Color fundus image, 2212x1659px
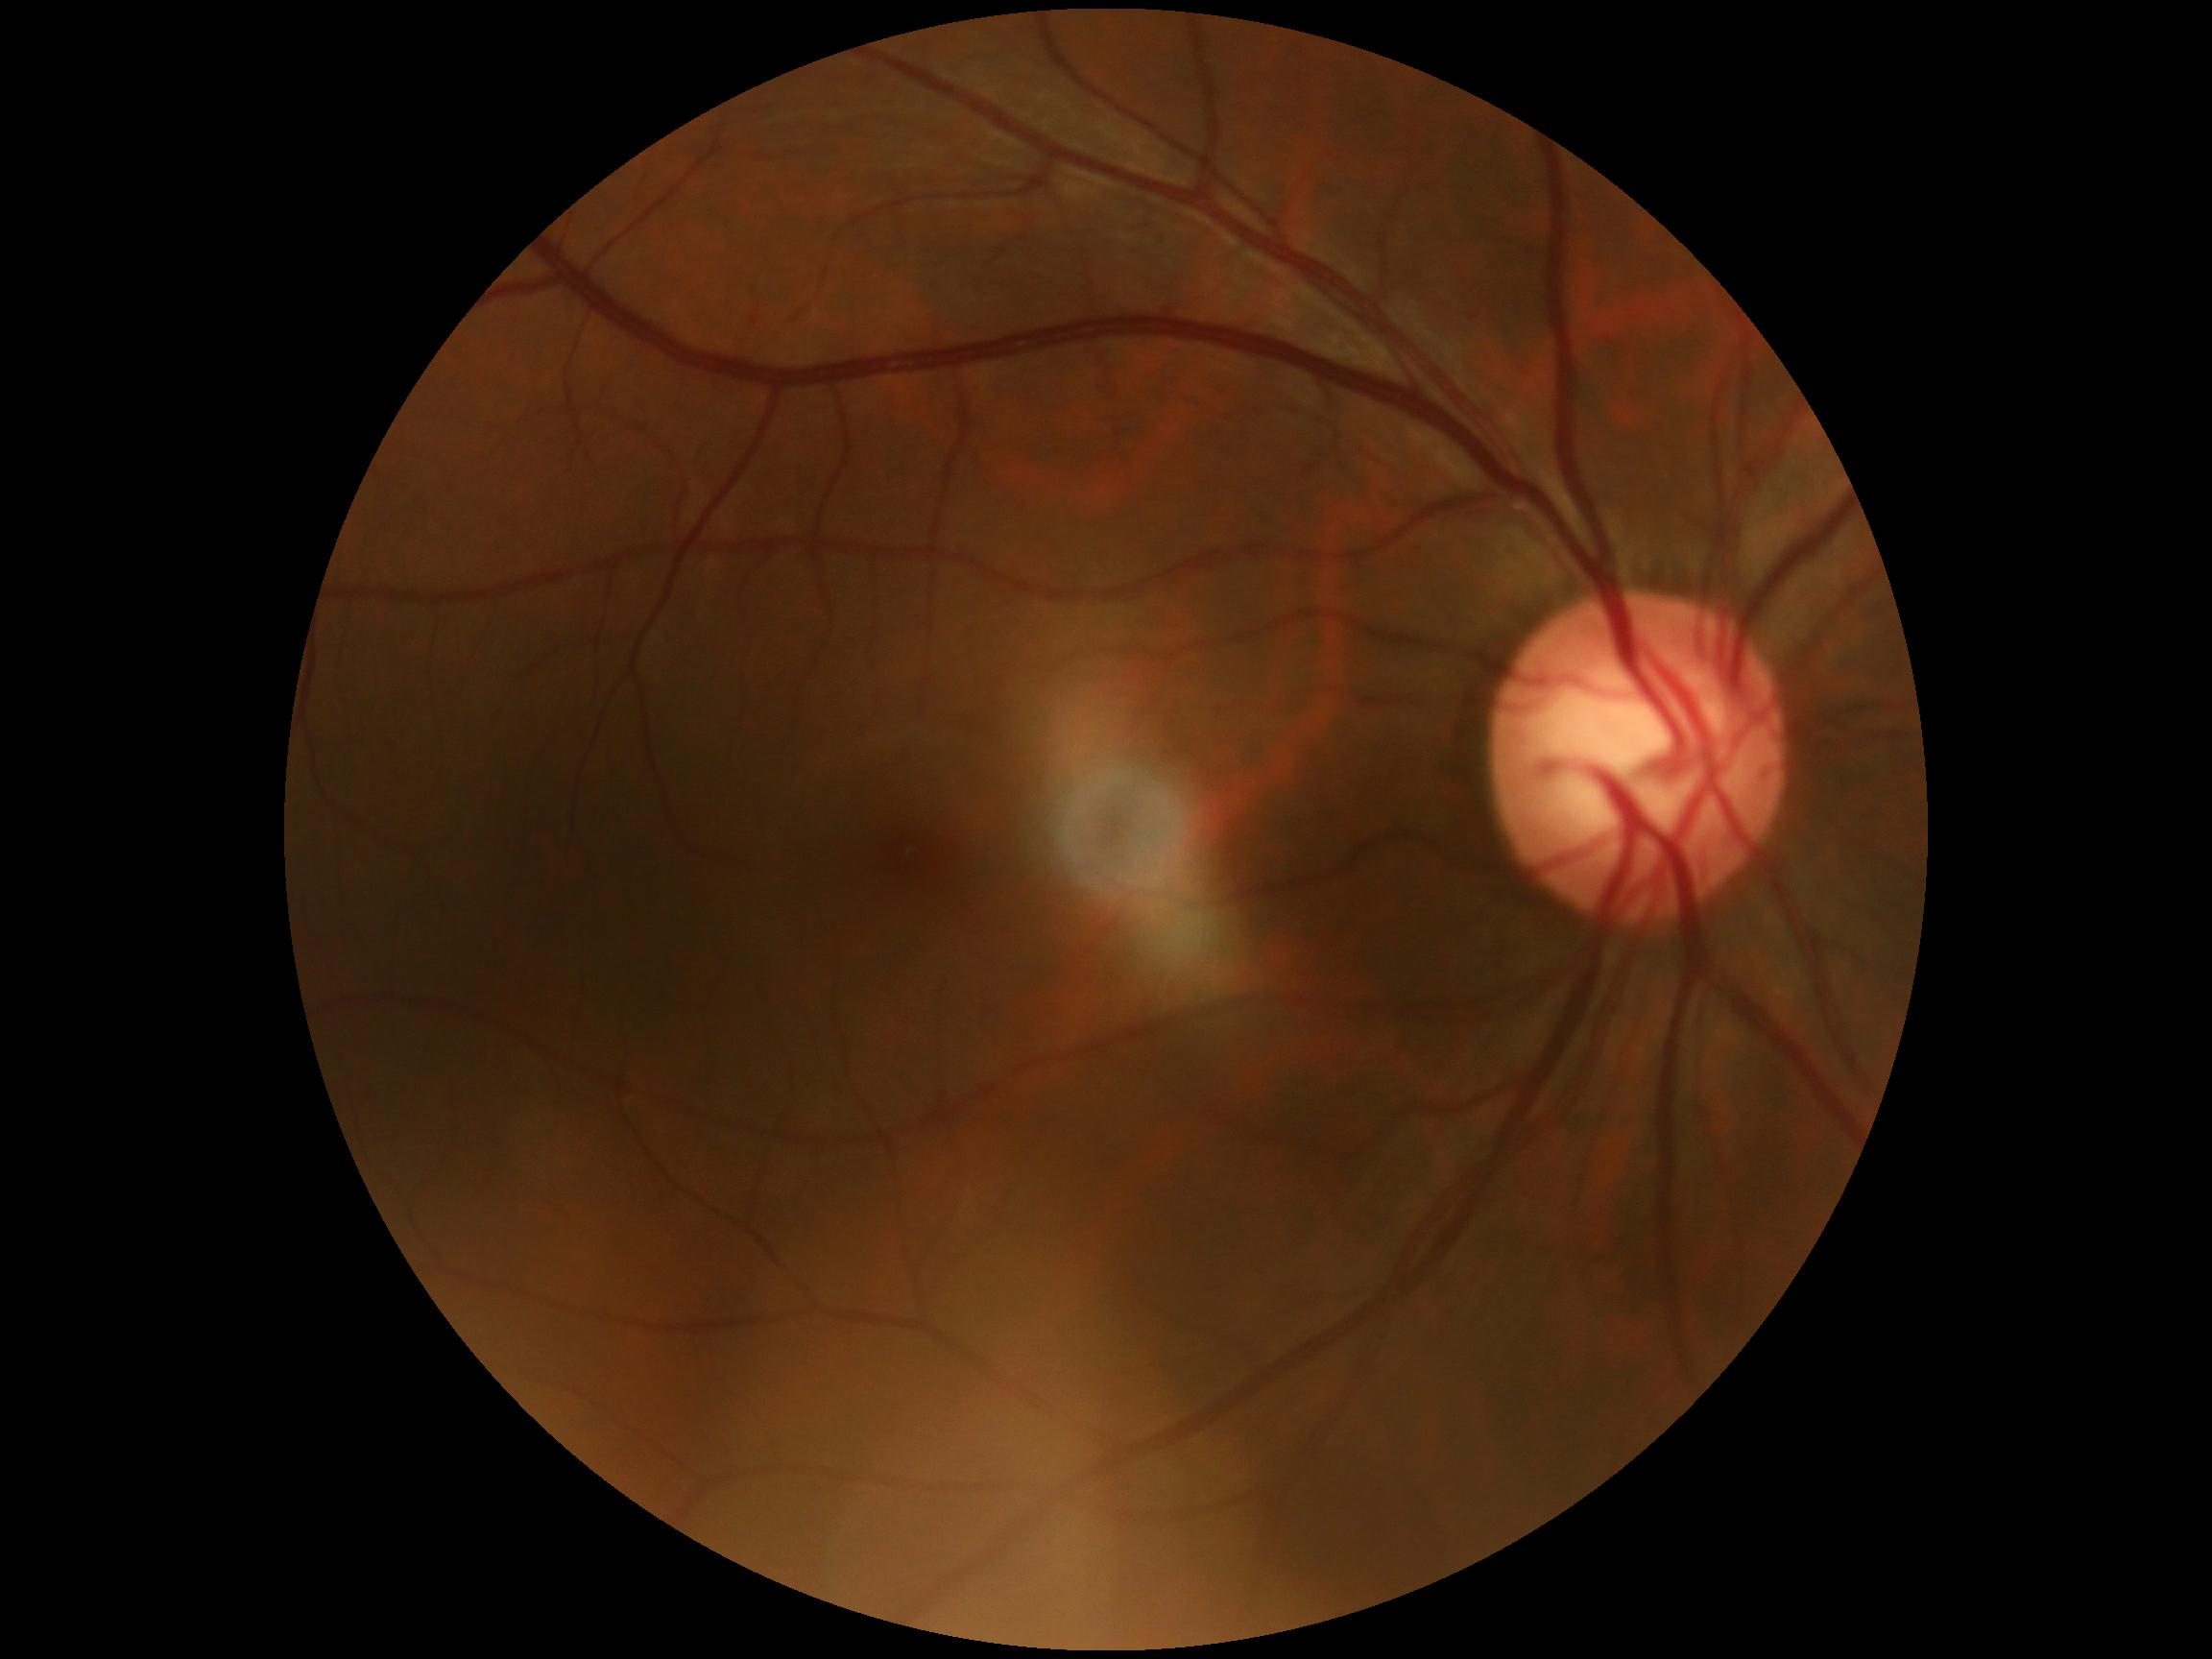 DR stage: grade 0 (no apparent retinopathy).